Davis DR grading
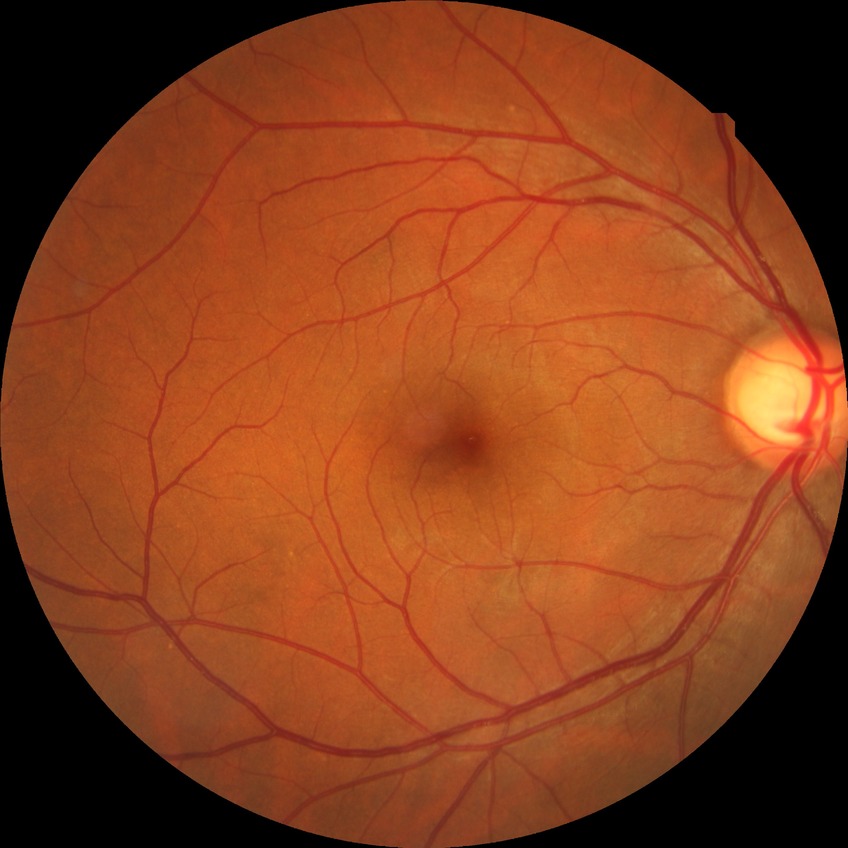

Diabetic retinopathy severity is no diabetic retinopathy.